848 x 848 pixels: 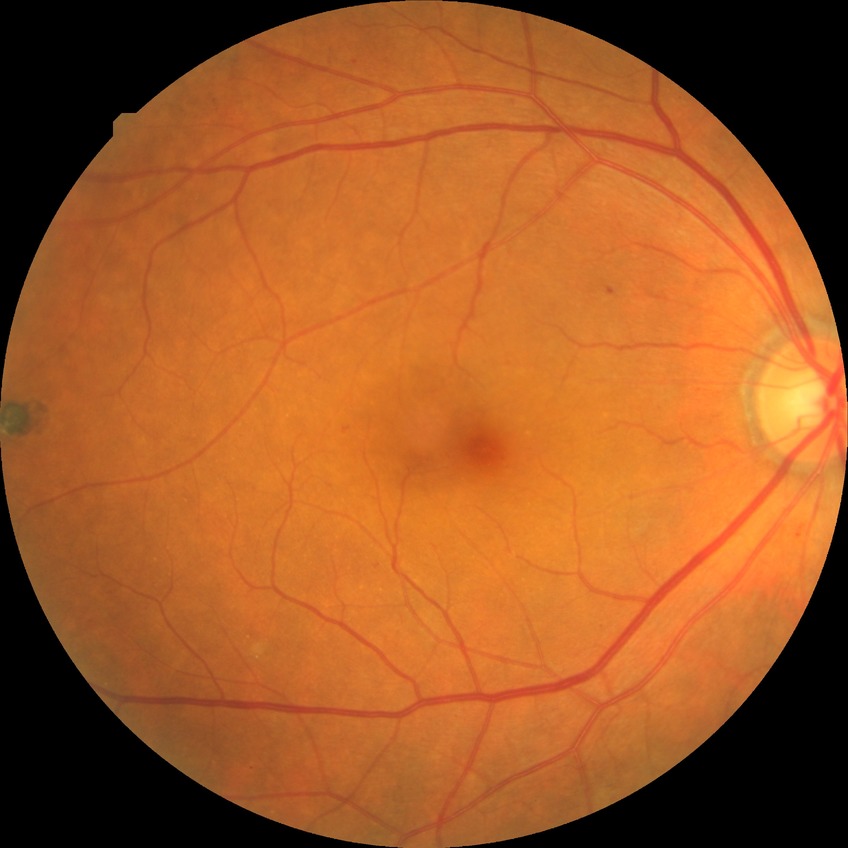

Diabetic retinopathy (DR) is simple diabetic retinopathy (SDR).